NIDEK AFC-230; modified Davis grading; 45° FOV.
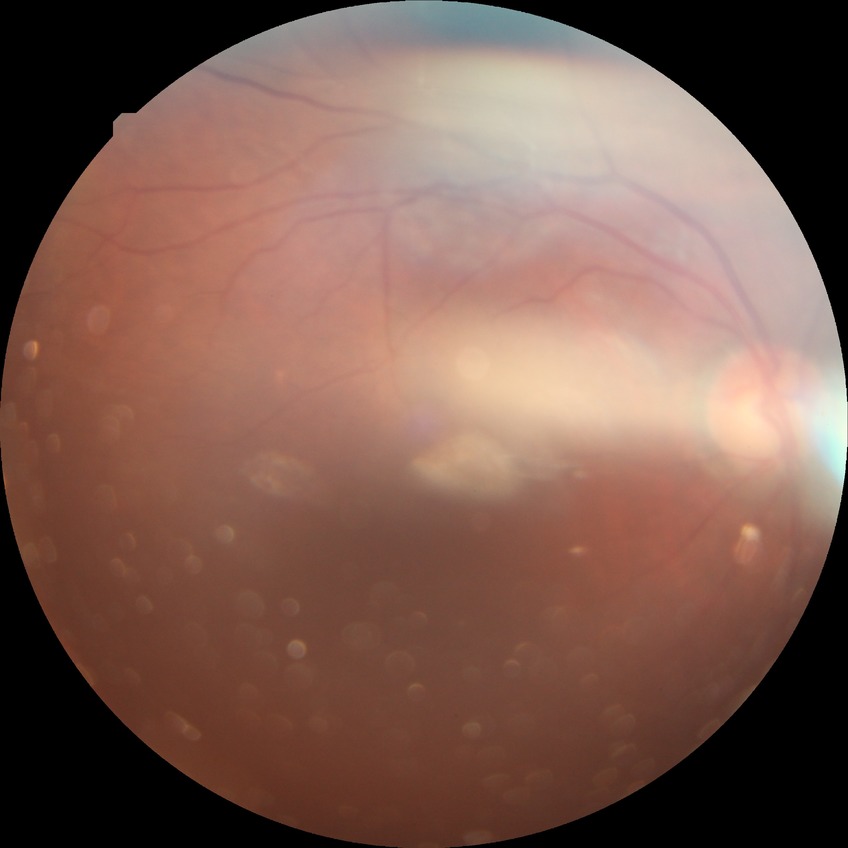
DR grade: NDR.